45° FOV — 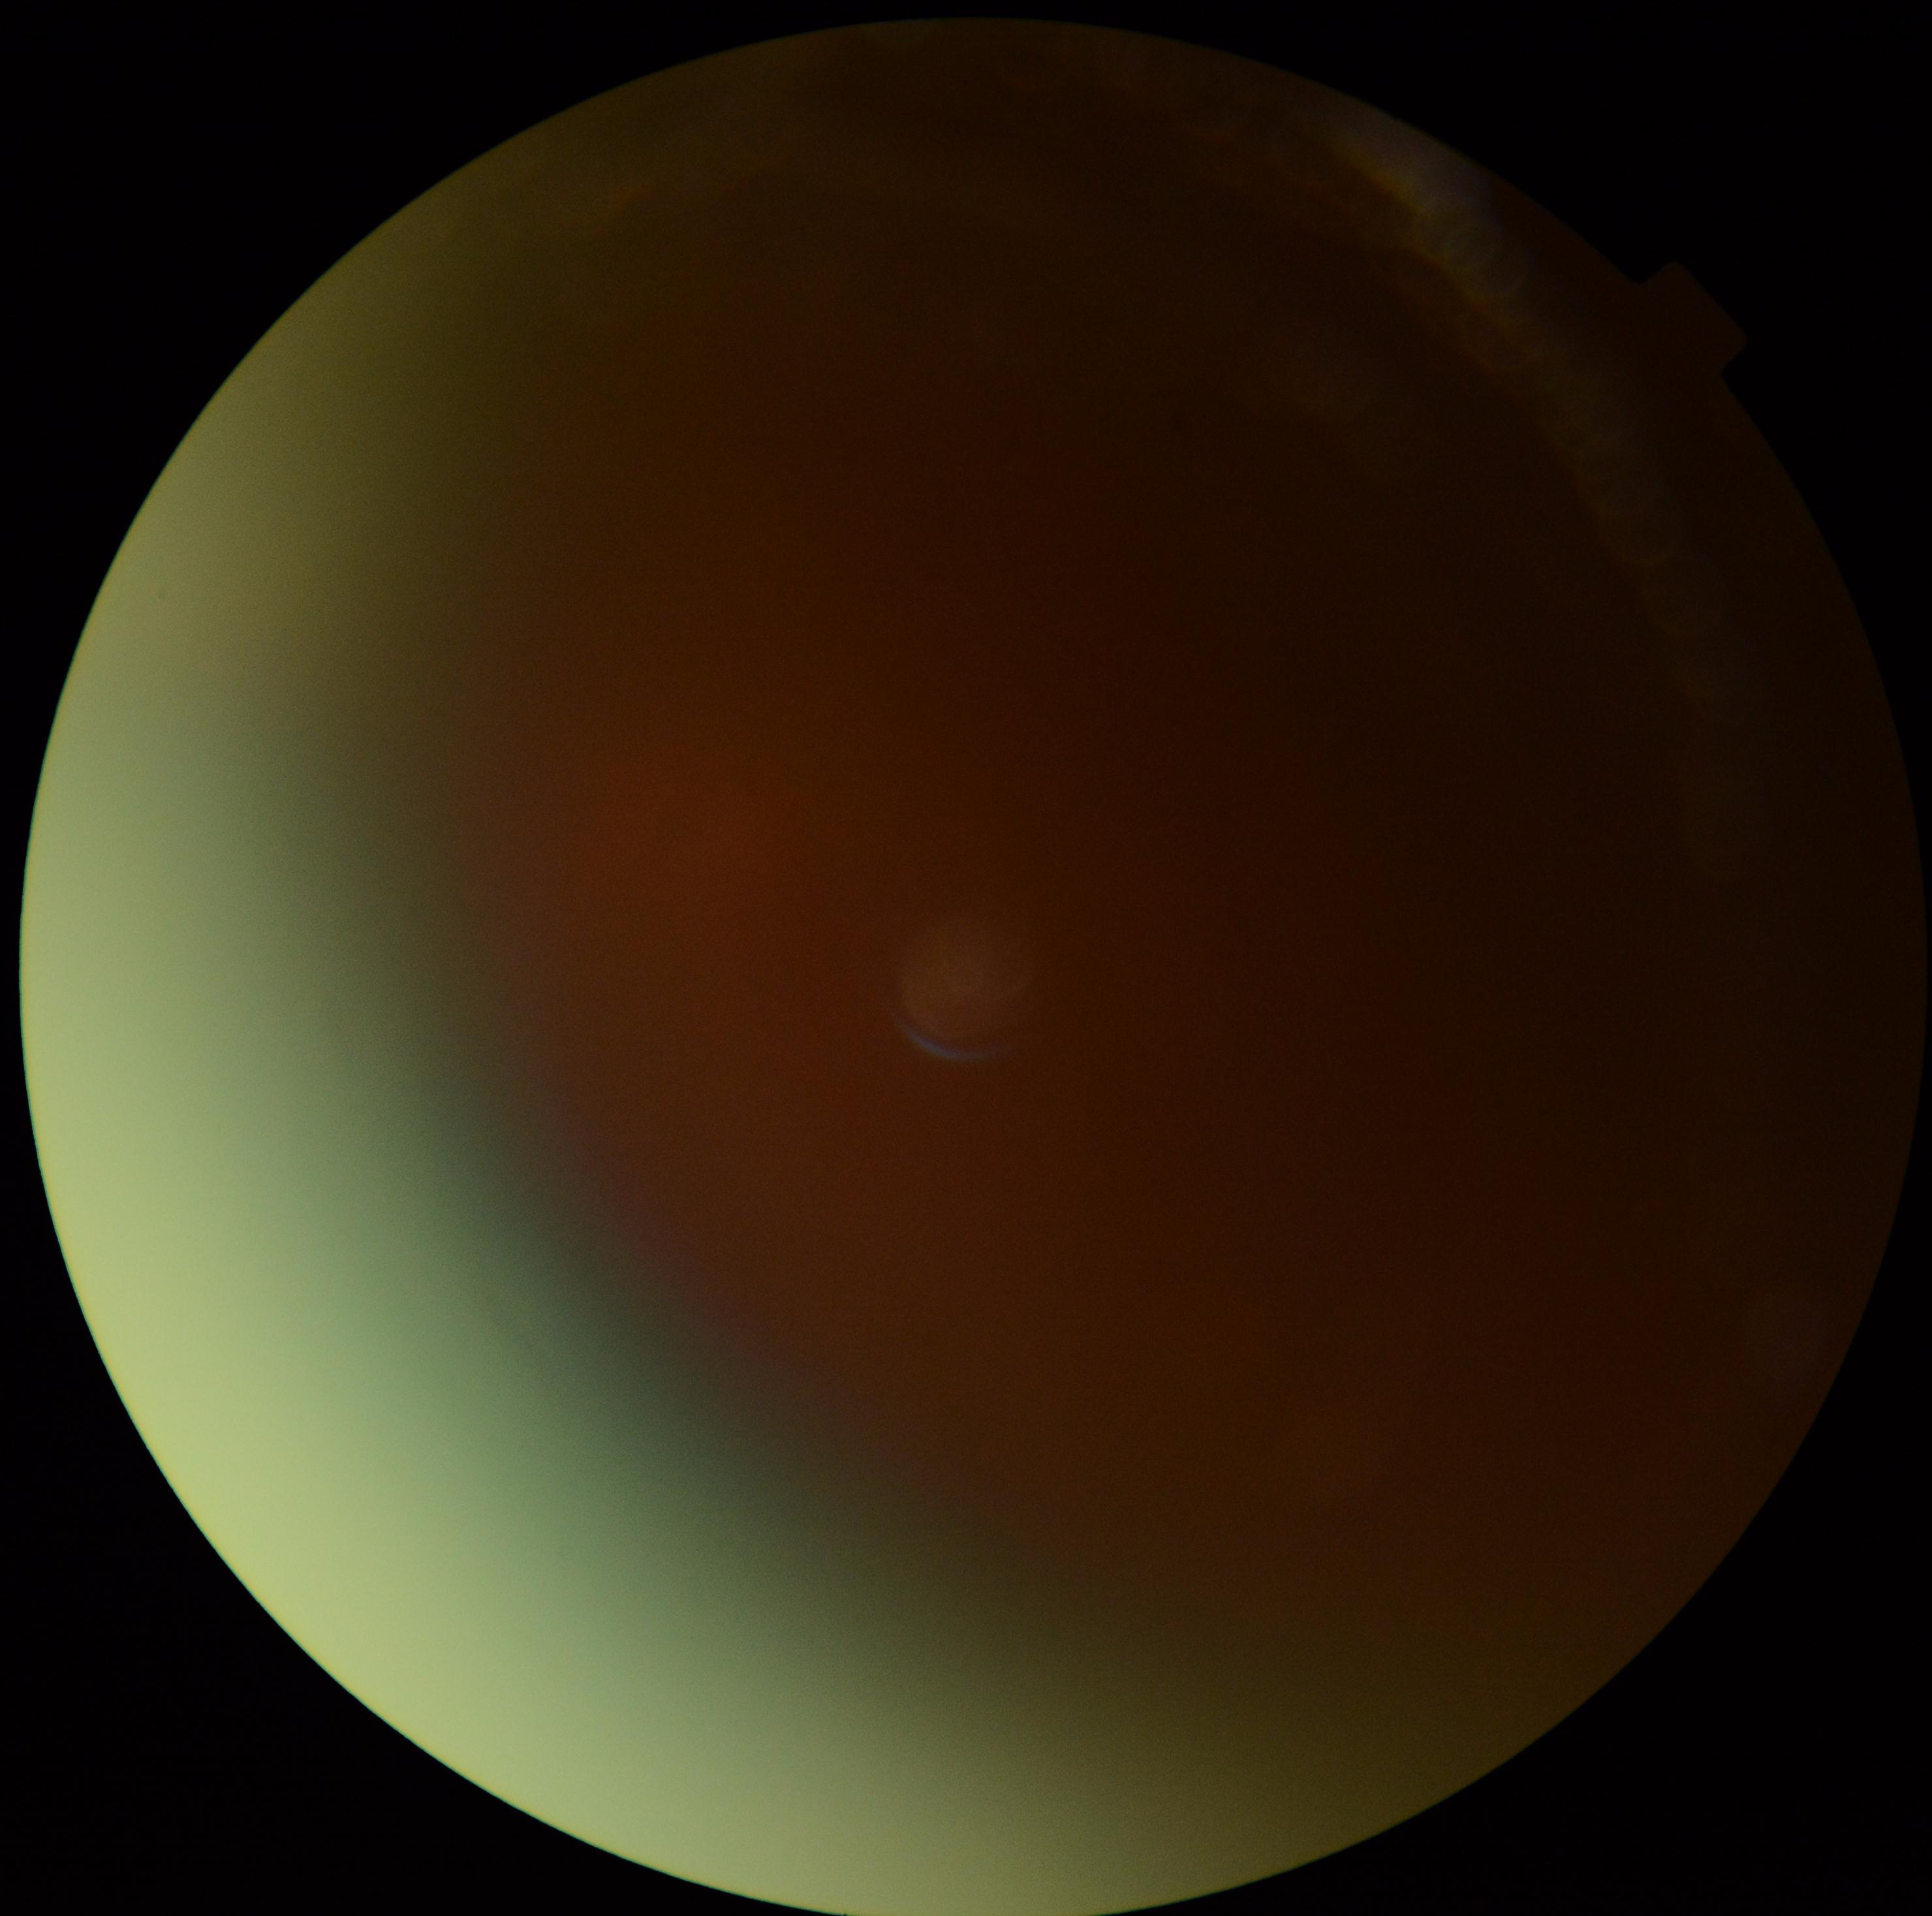

Ungradable image — DR severity cannot be determined.
Diabetic retinopathy (DR): ungradable.